50° FOV · retinal fundus photograph · 1924x1556 — 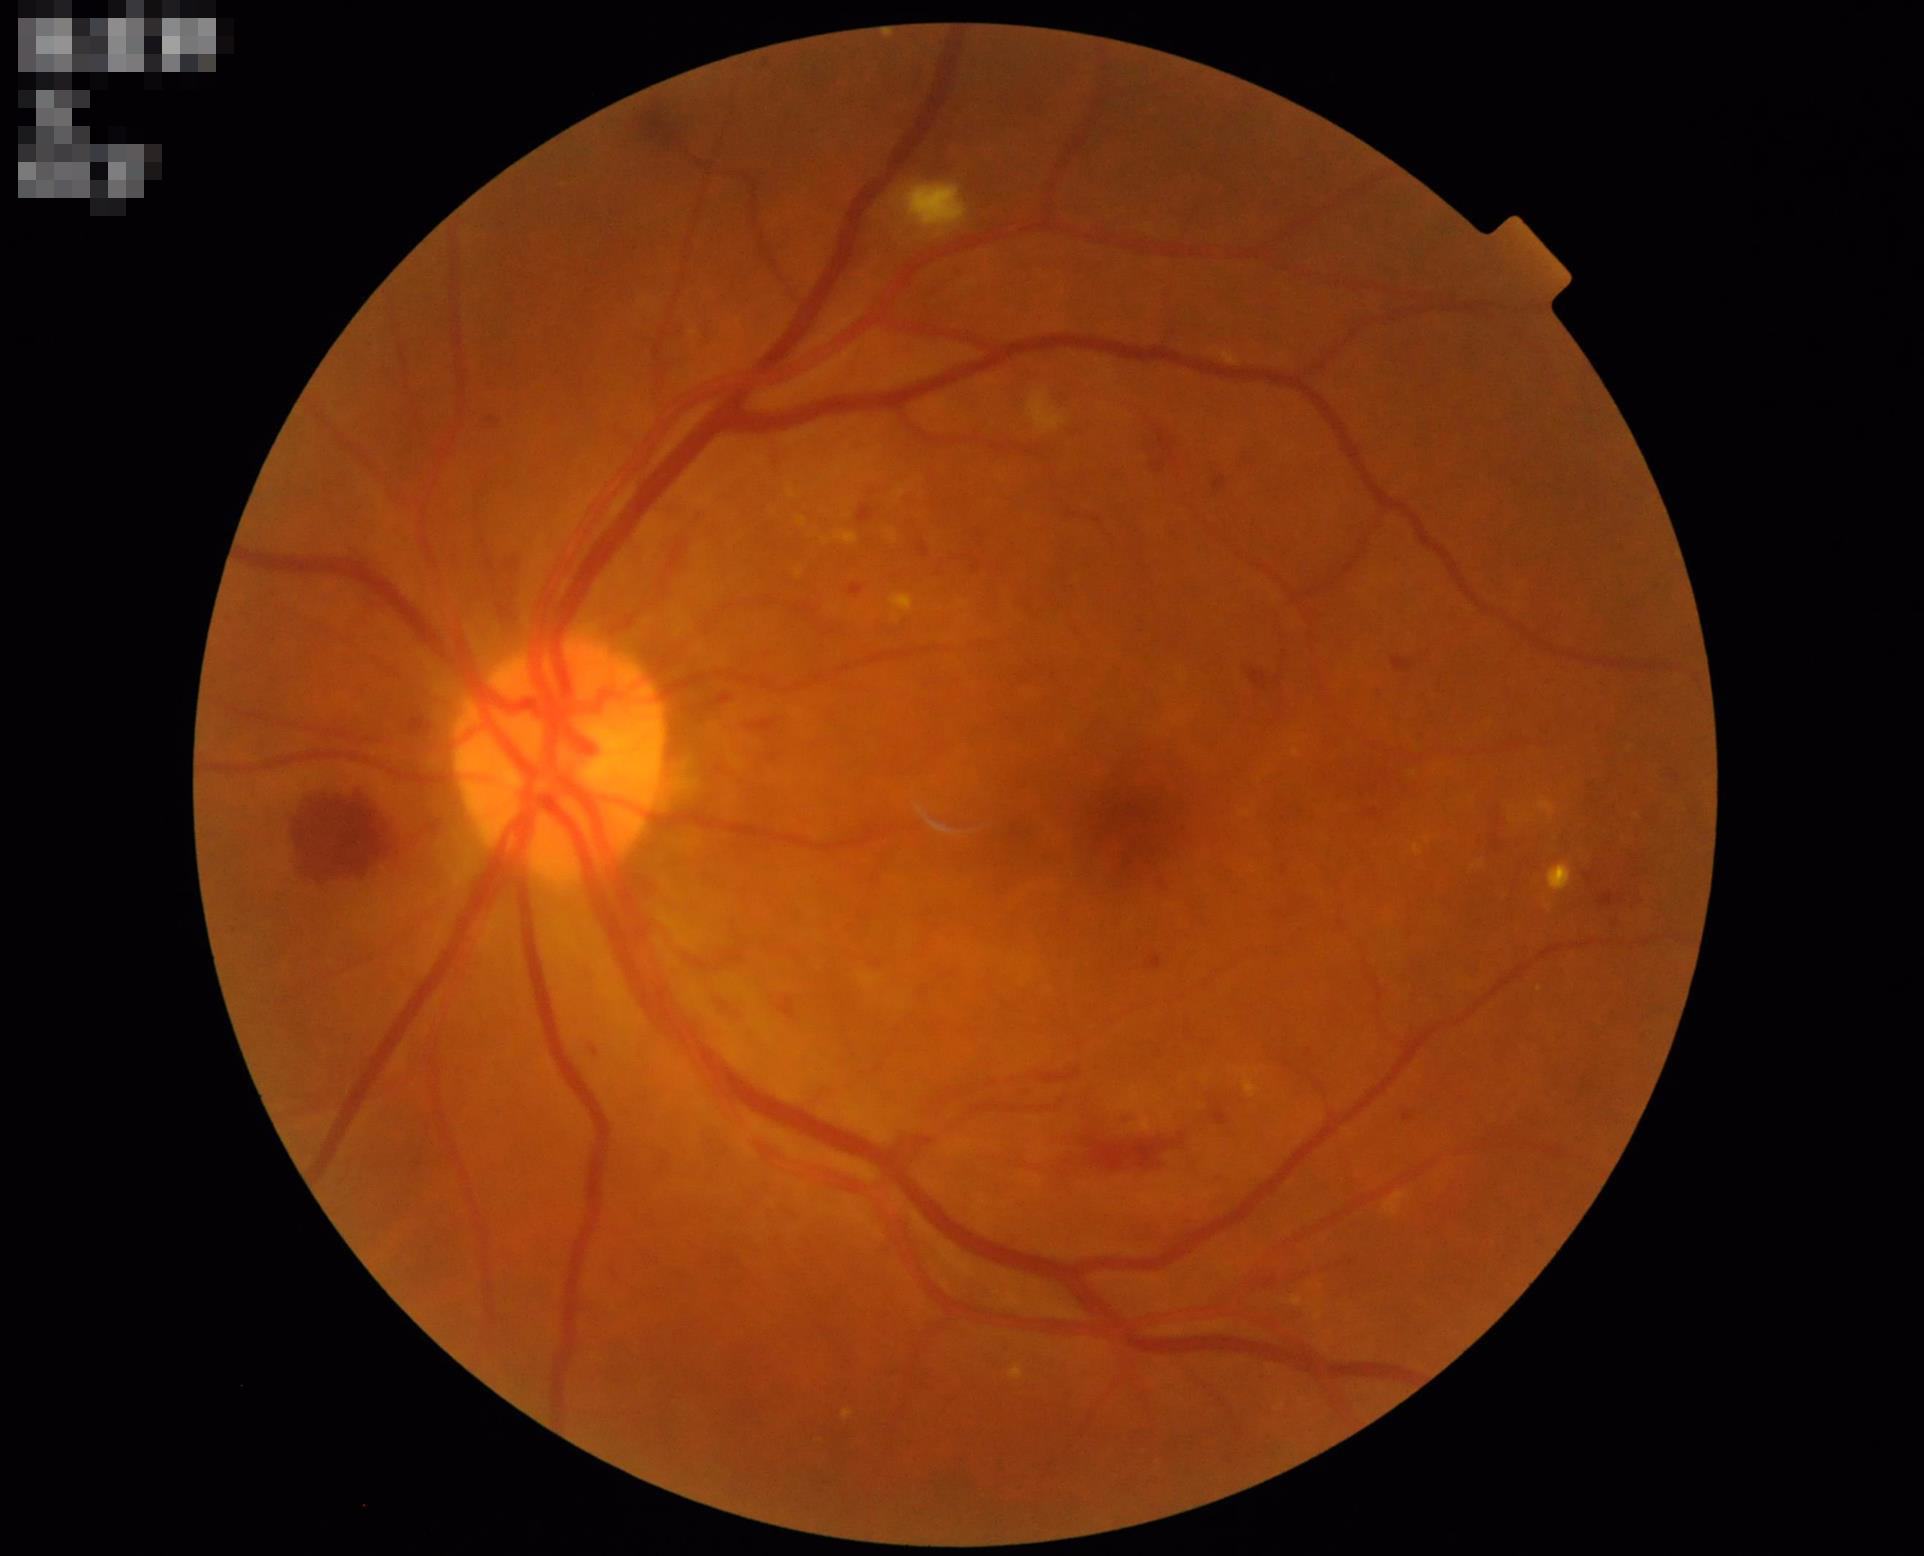
Contrast: adequate
Overall: satisfactory
Illumination: adequate